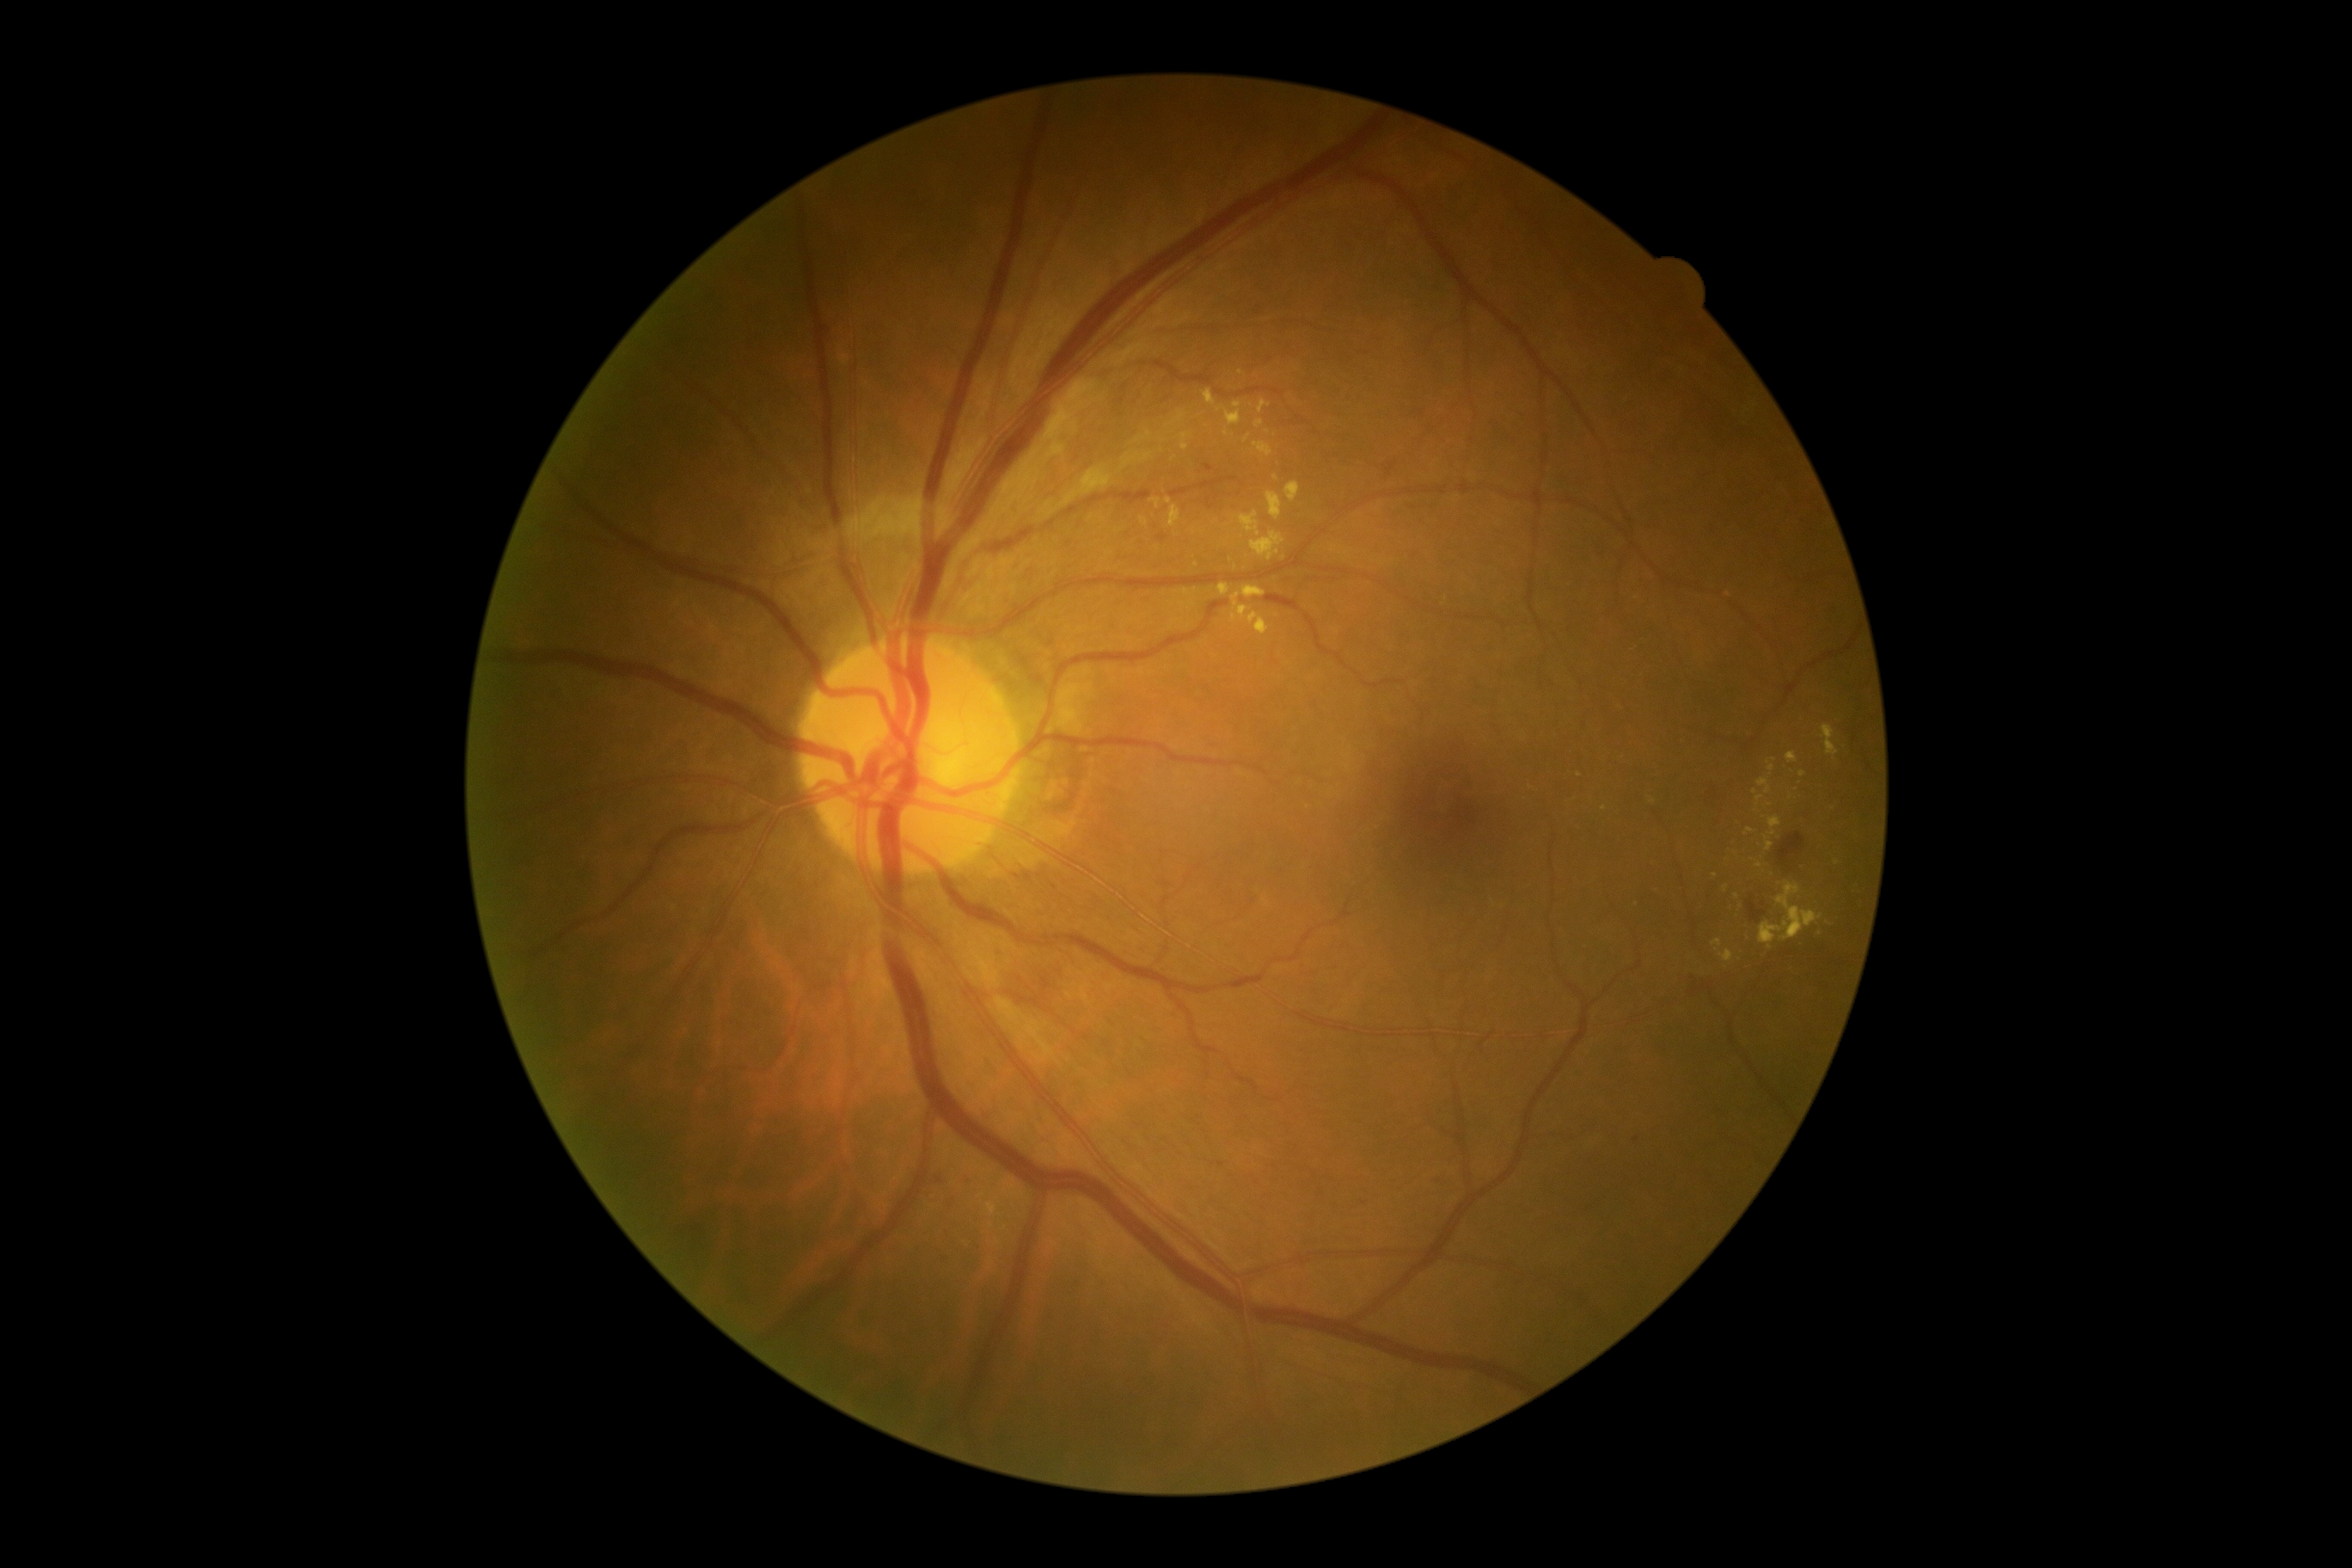
Disease class: non-proliferative diabetic retinopathy. DR: grade 2.